Image size 2346x1568 — 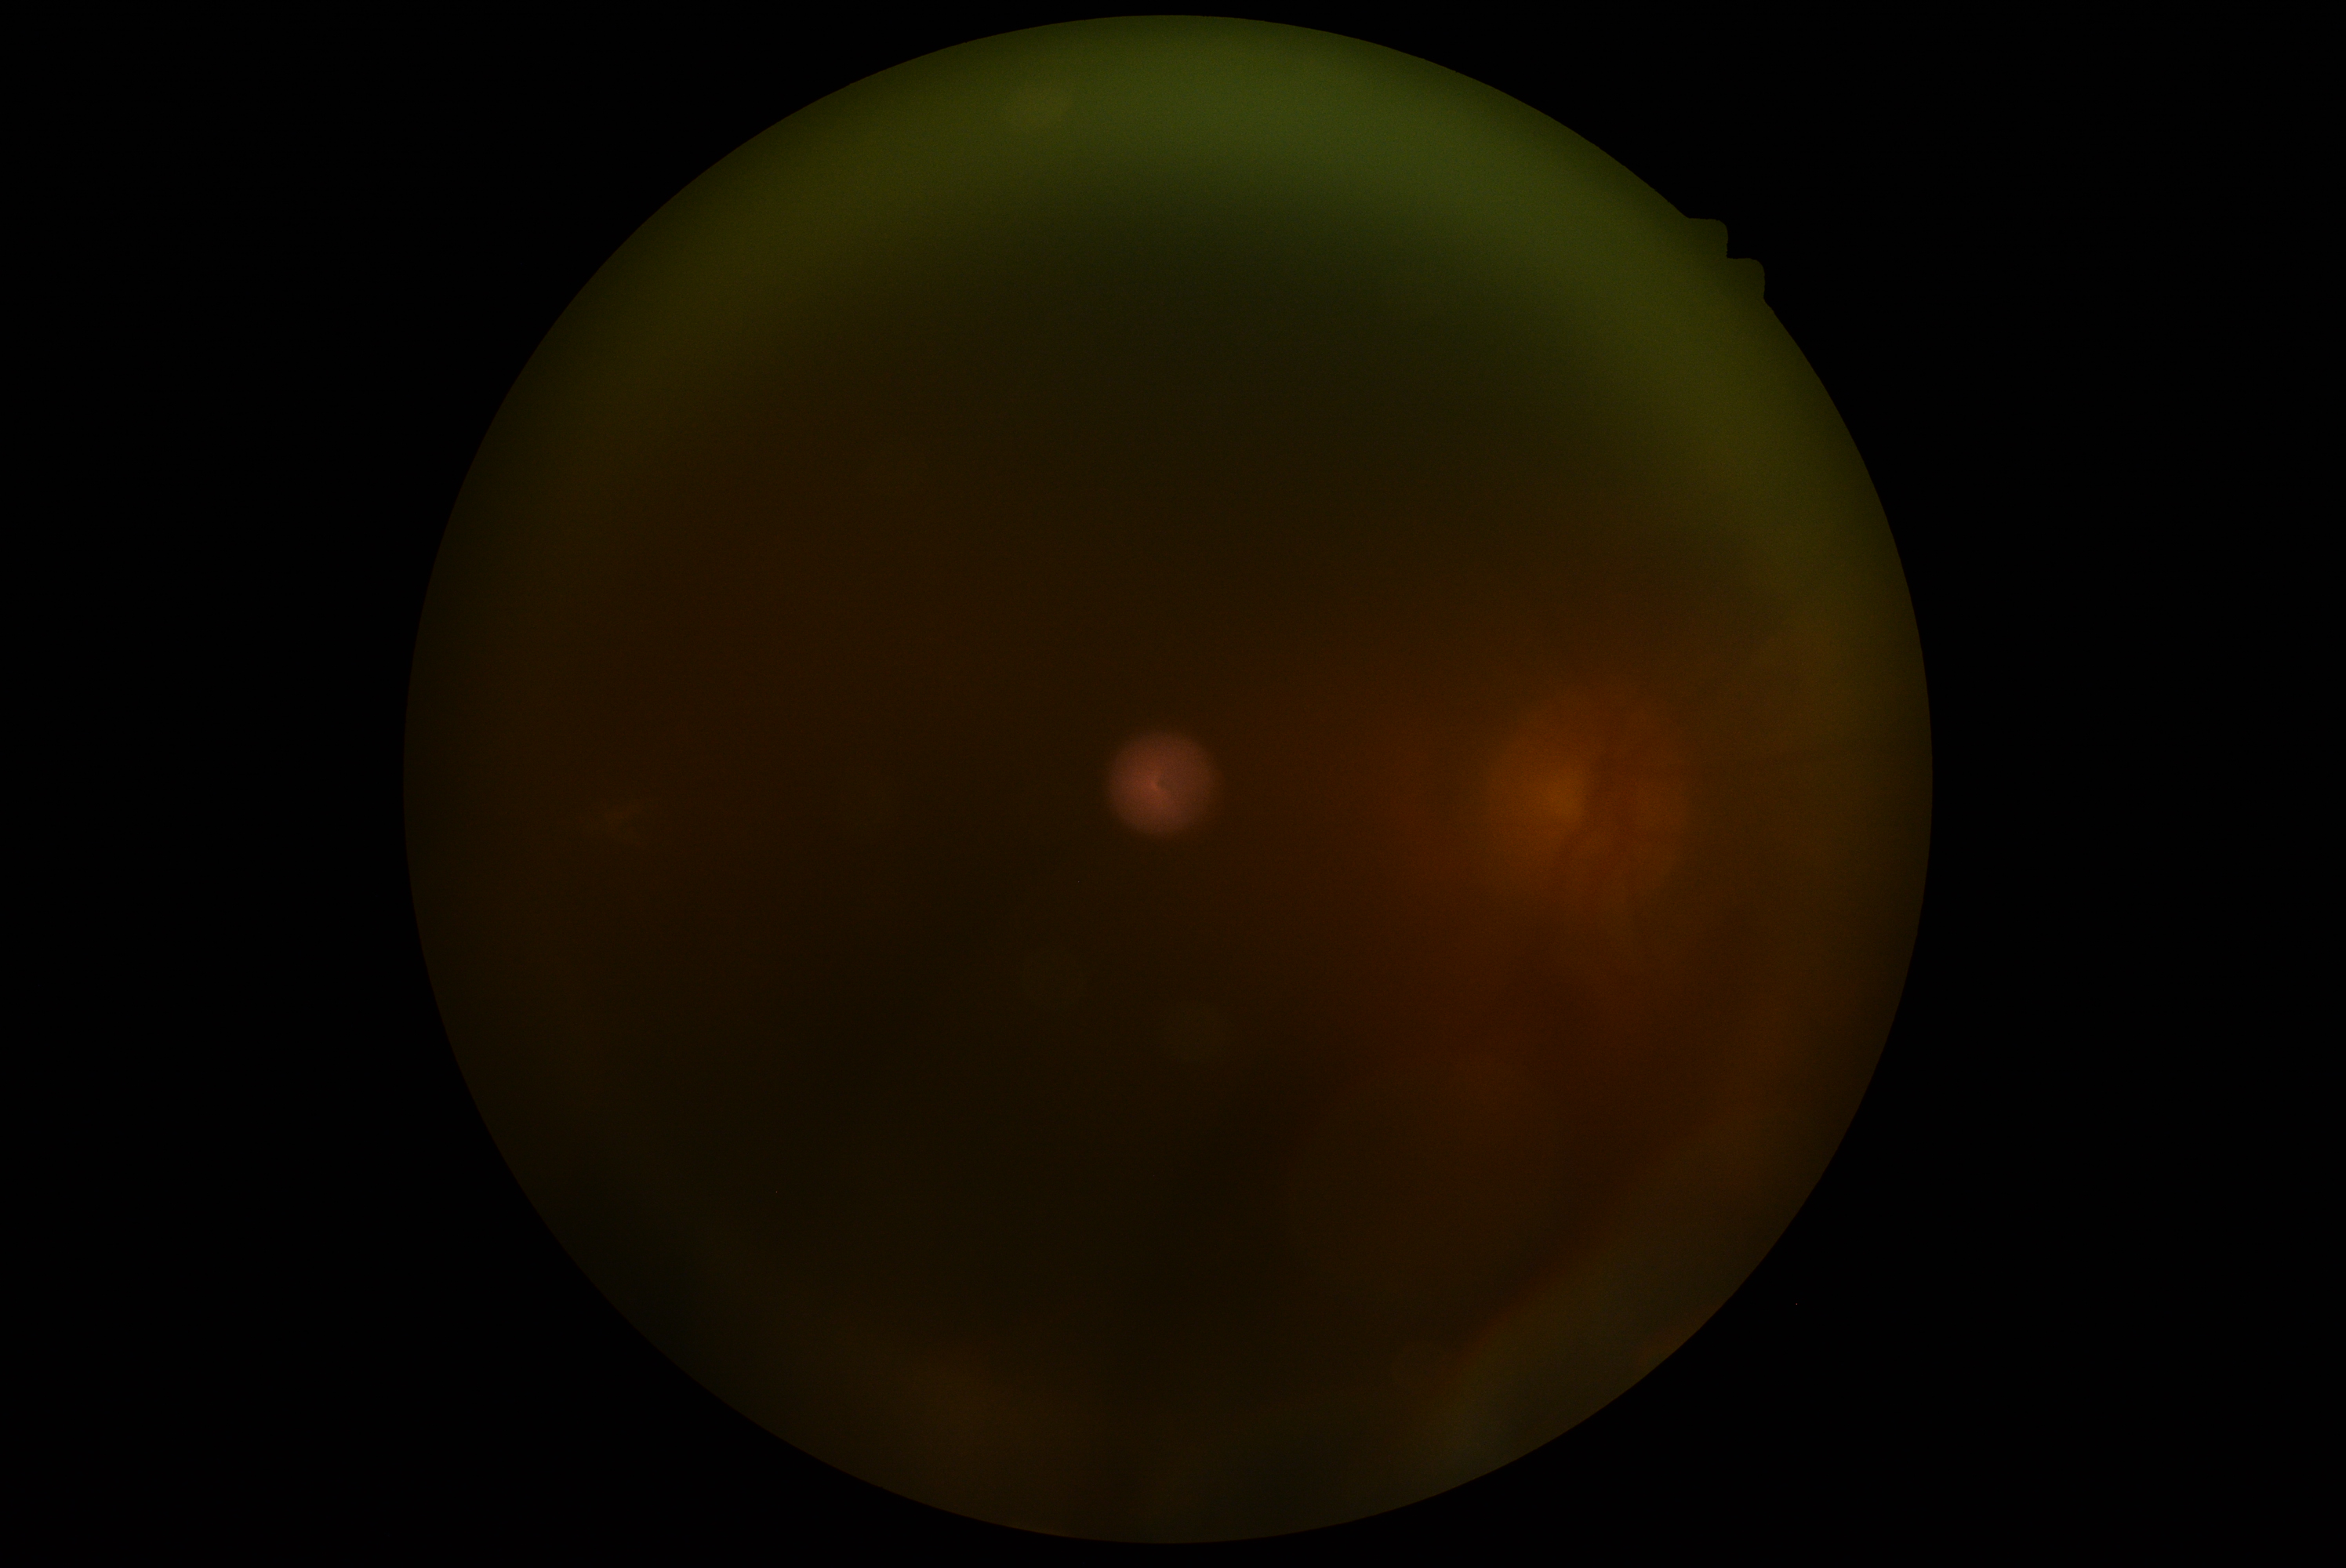 dr_grade: ungradable due to poor image quality
quality: insufficient for DR assessment